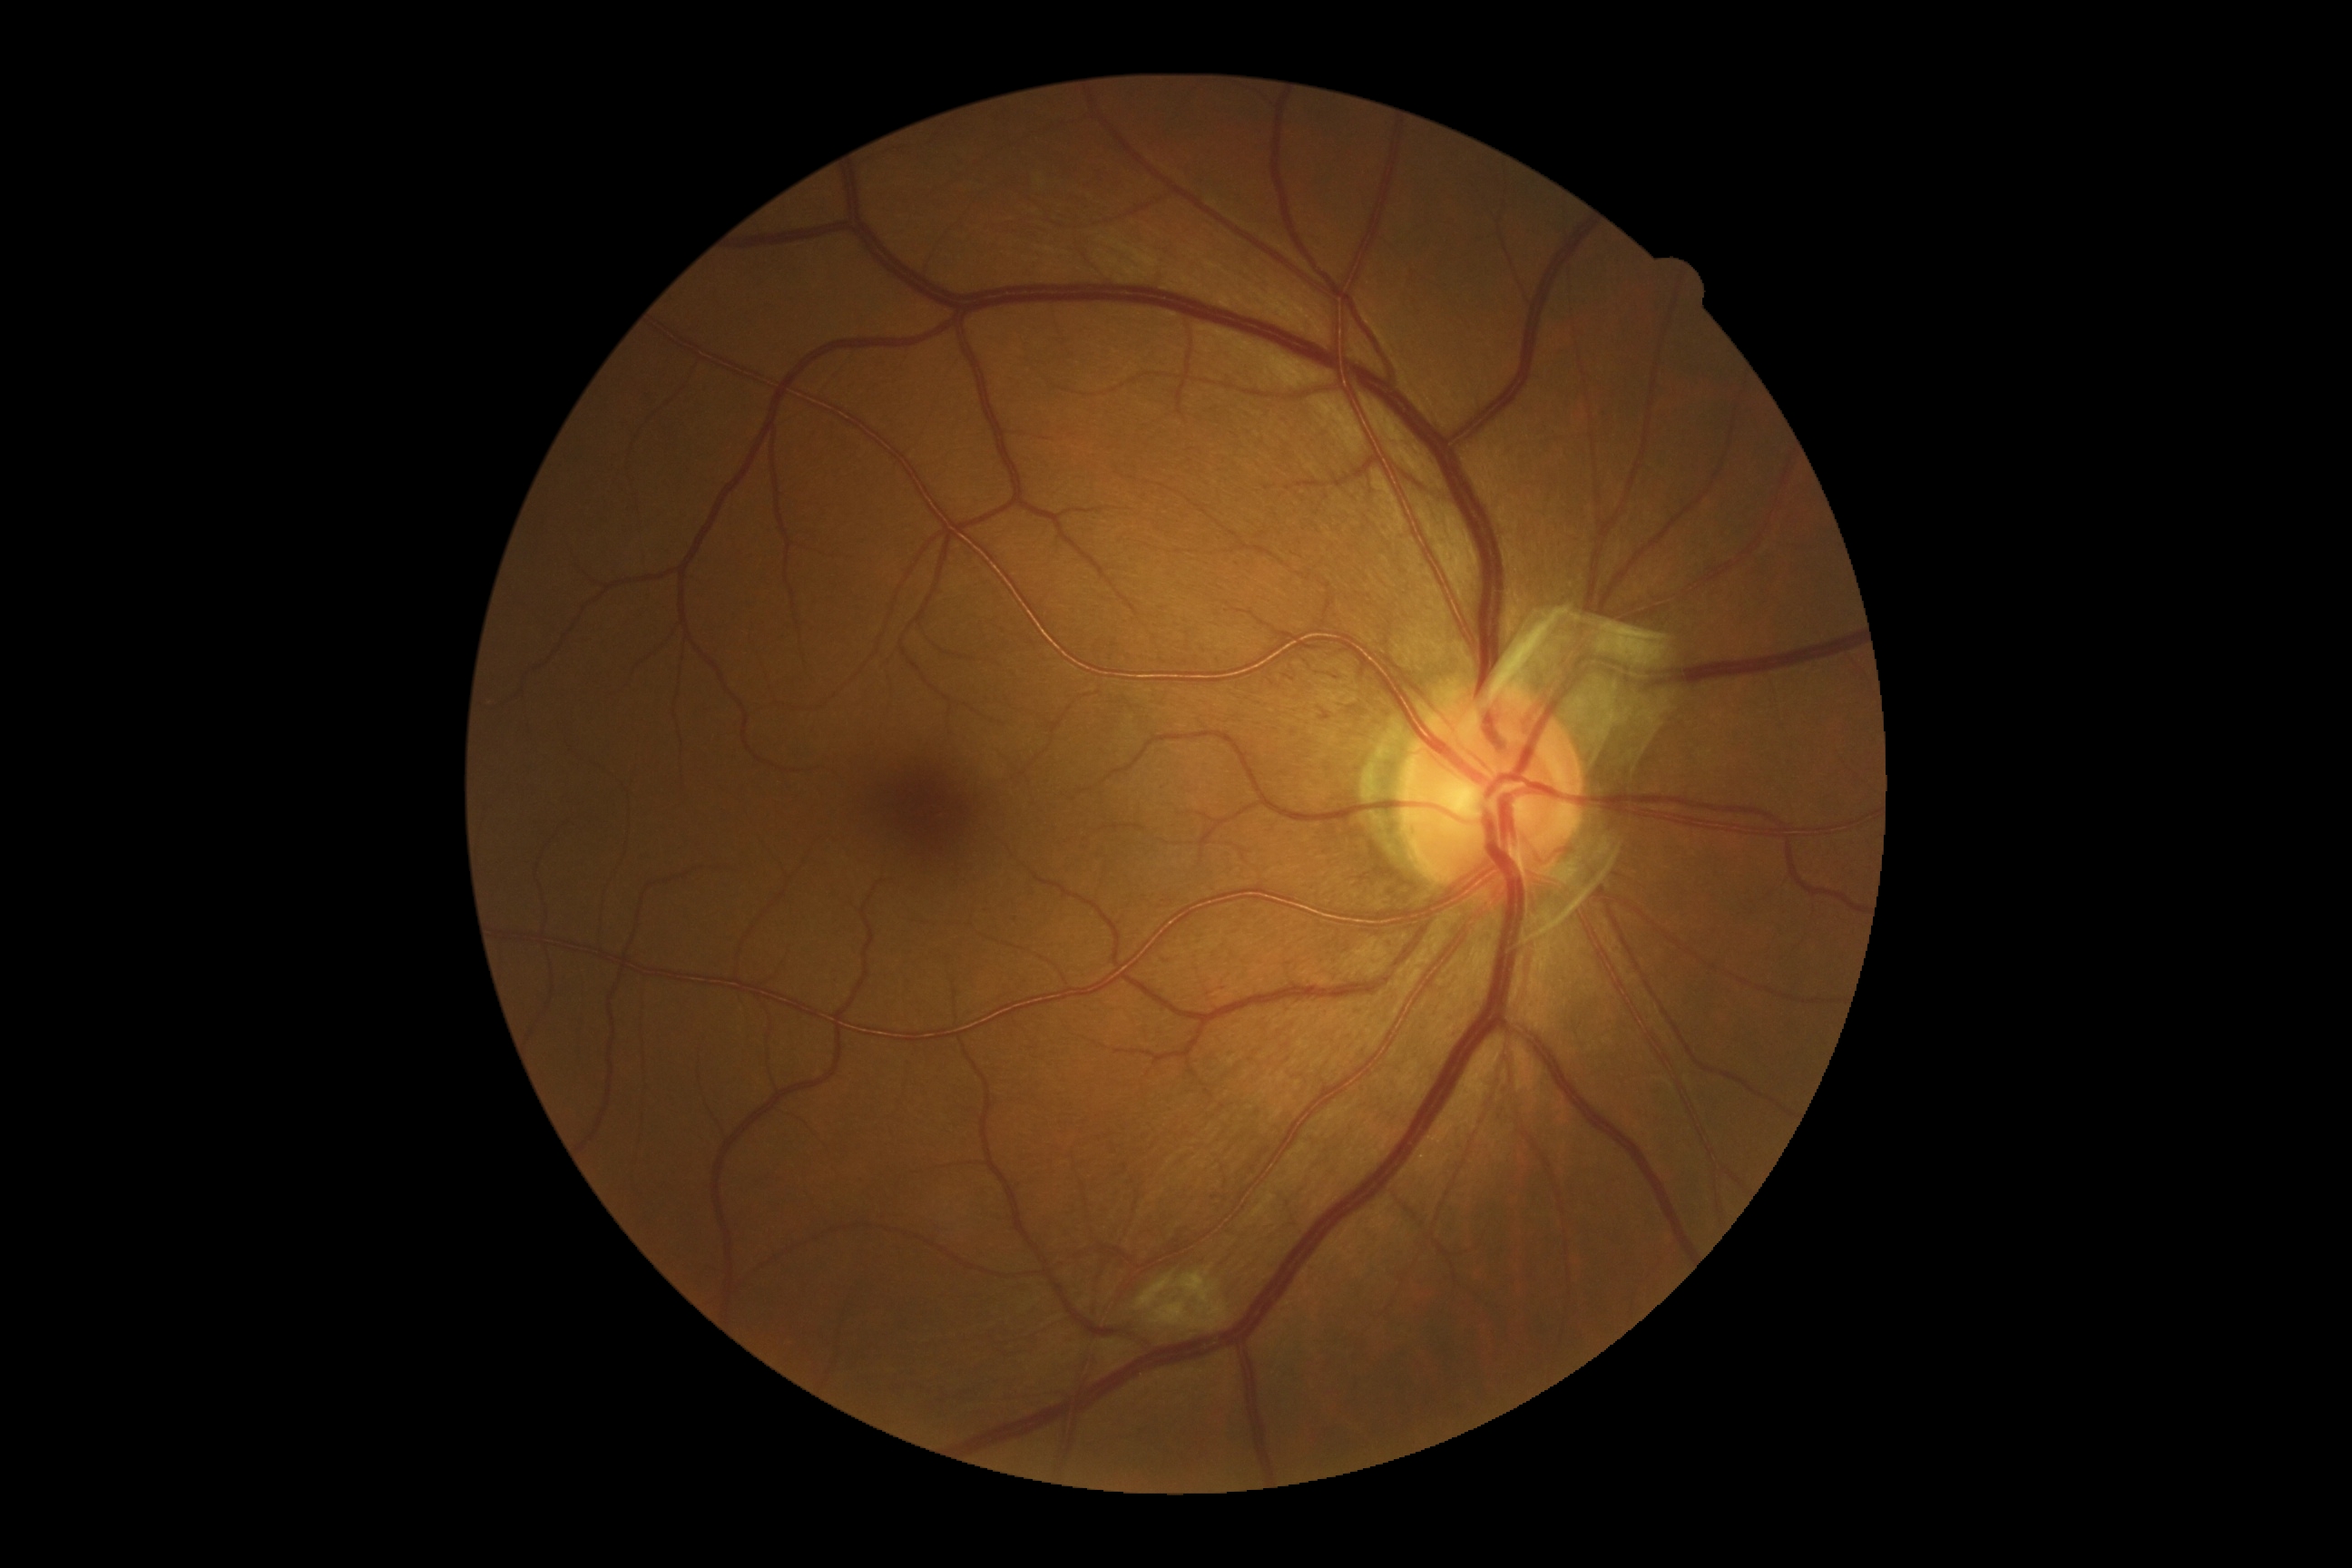
DR severity: moderate non-proliferative diabetic retinopathy (grade 2).